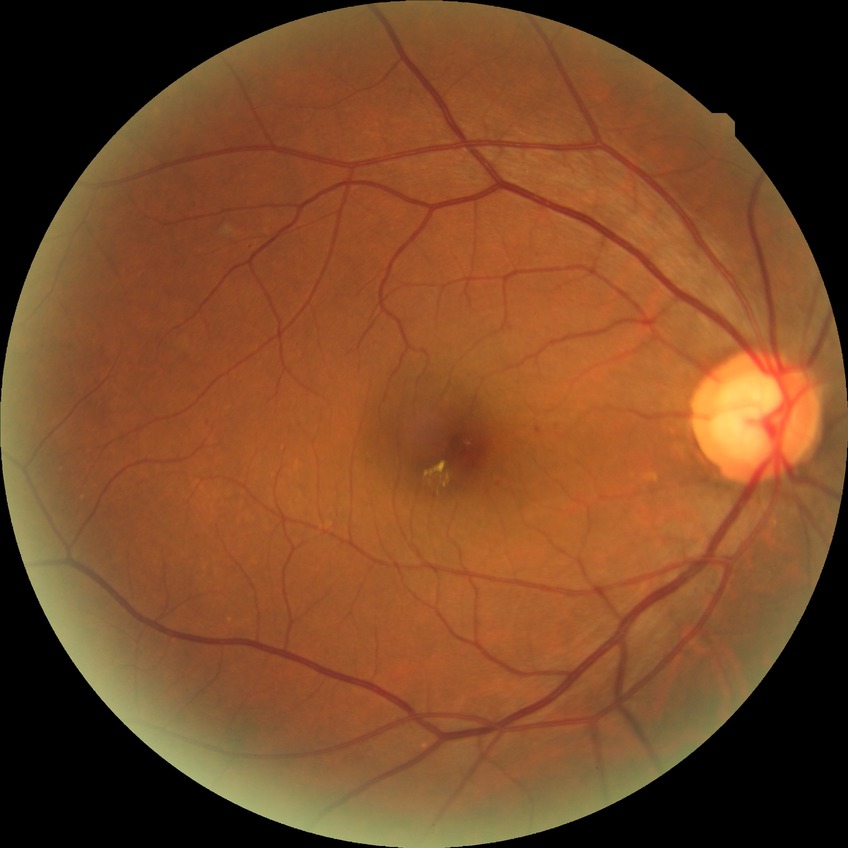

Diabetic retinopathy (DR) is SDR (simple diabetic retinopathy). DR class: non-proliferative diabetic retinopathy.